Modified Davis grading; FOV: 45 degrees
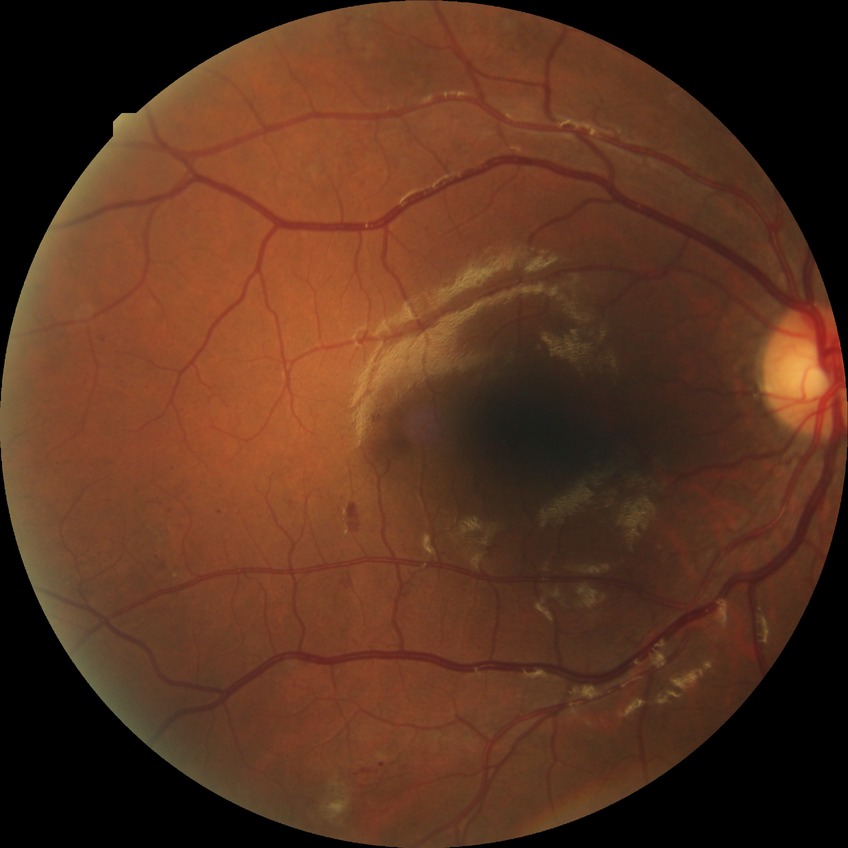

DR class: non-proliferative diabetic retinopathy.
Diabetic retinopathy (DR): PPDR (pre-proliferative diabetic retinopathy).